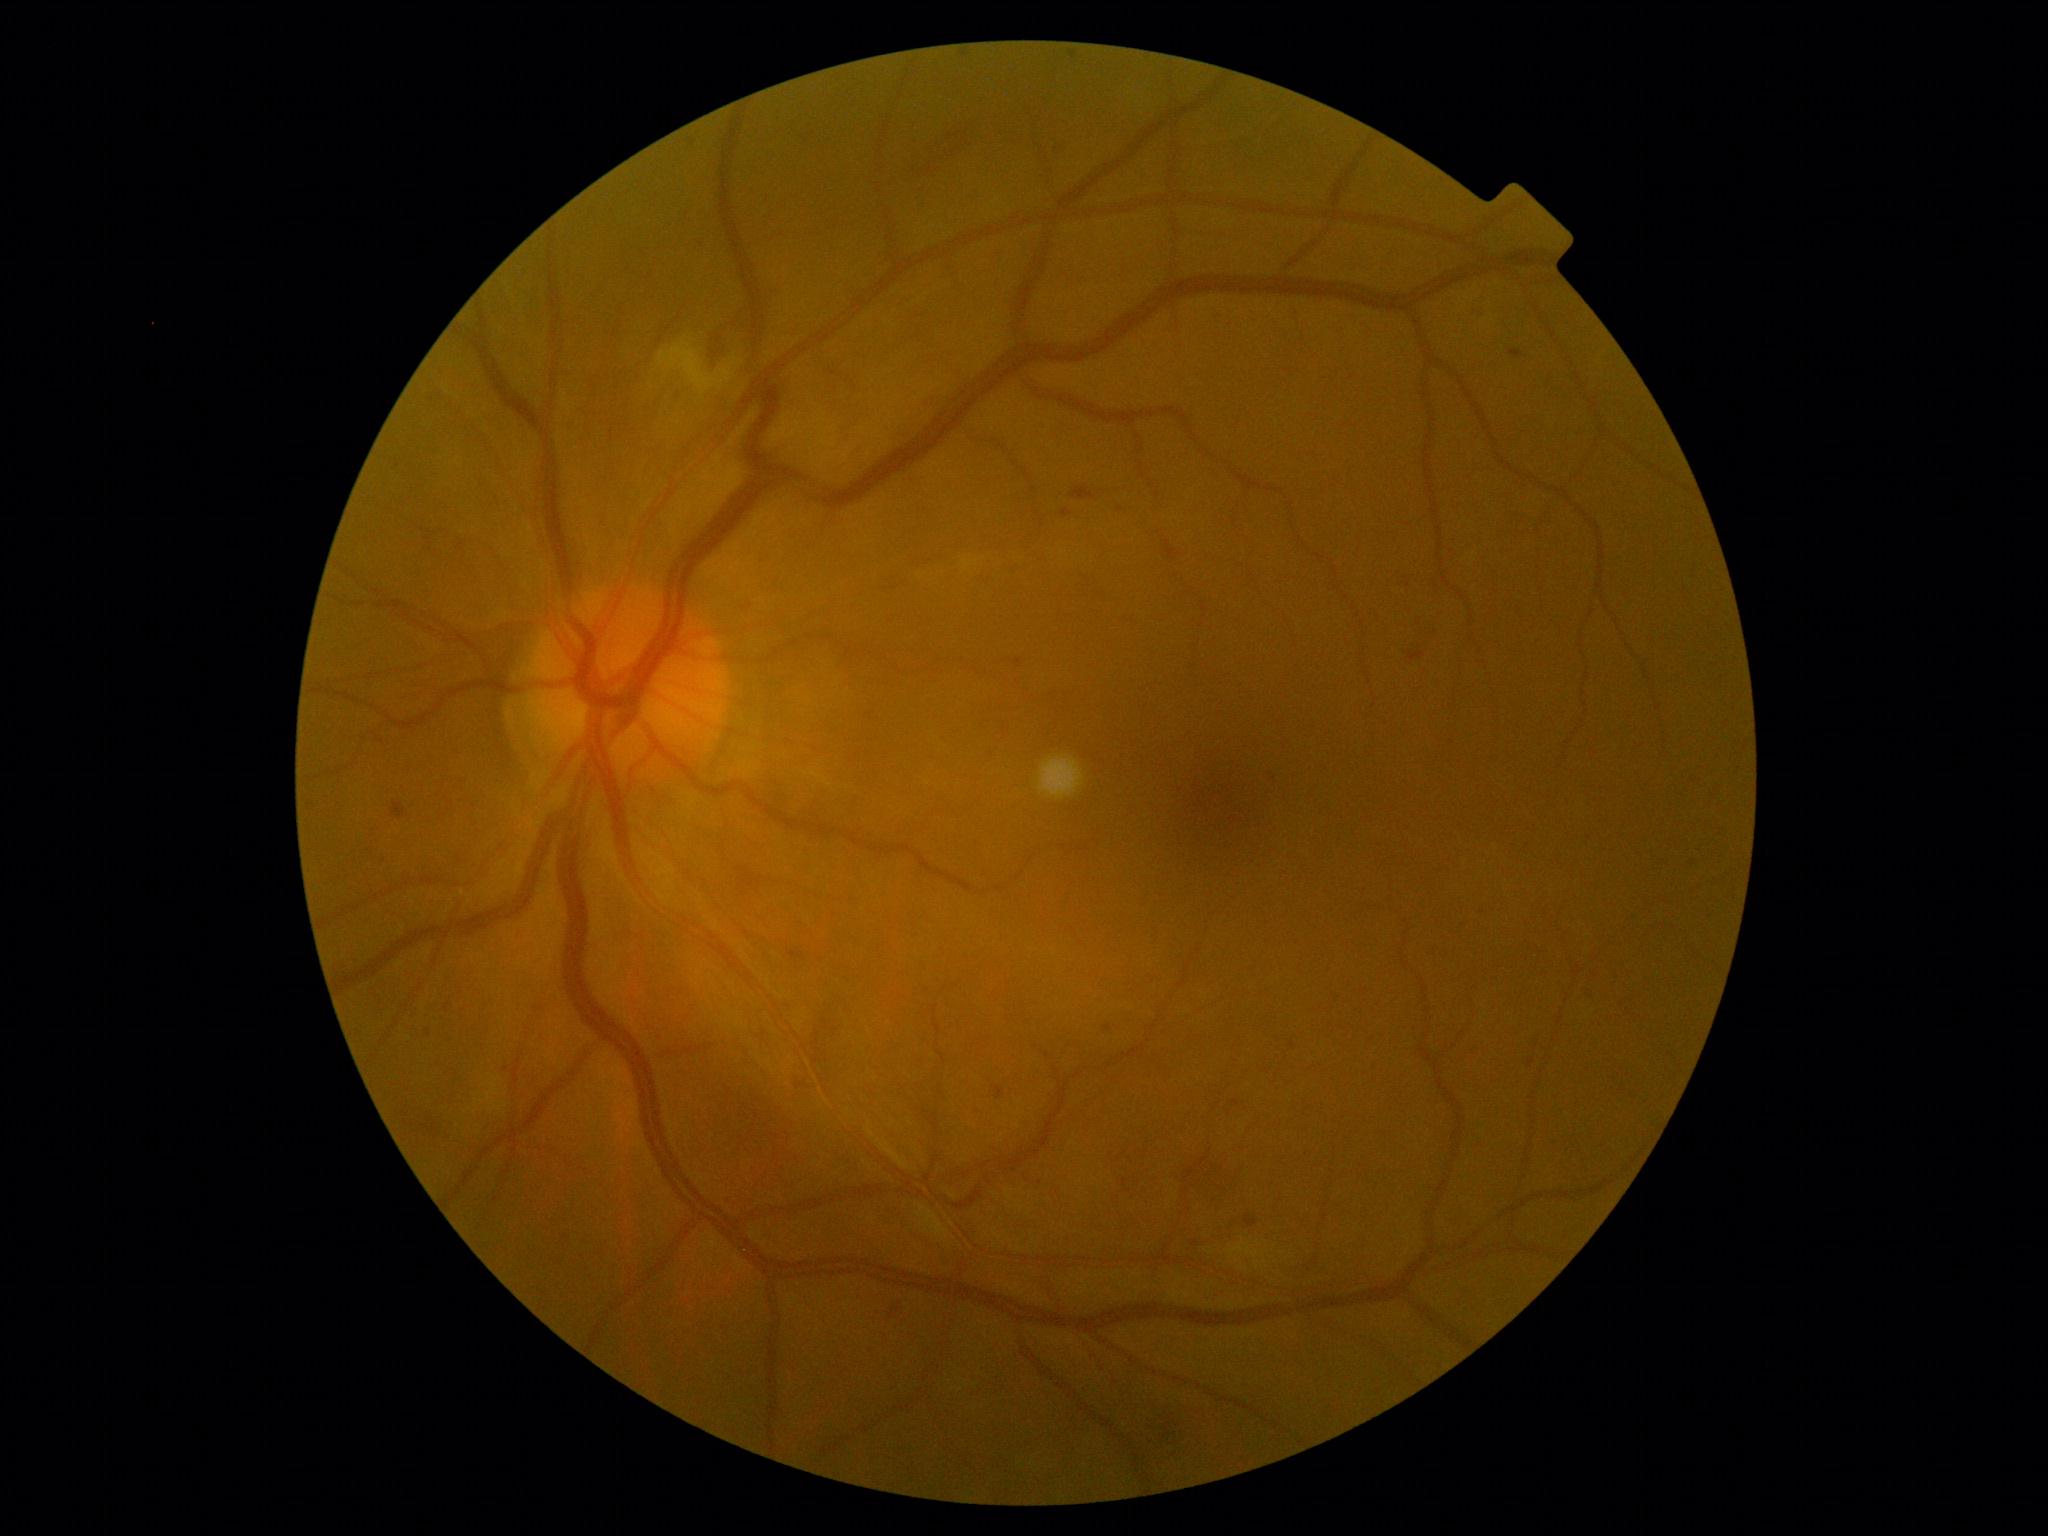 The retinopathy is classified as non-proliferative diabetic retinopathy.
Diabetic retinopathy (DR): moderate non-proliferative diabetic retinopathy (grade 2).